Color fundus image
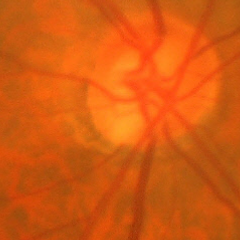

Glaucoma is present. Diagnosis: early-stage glaucoma.